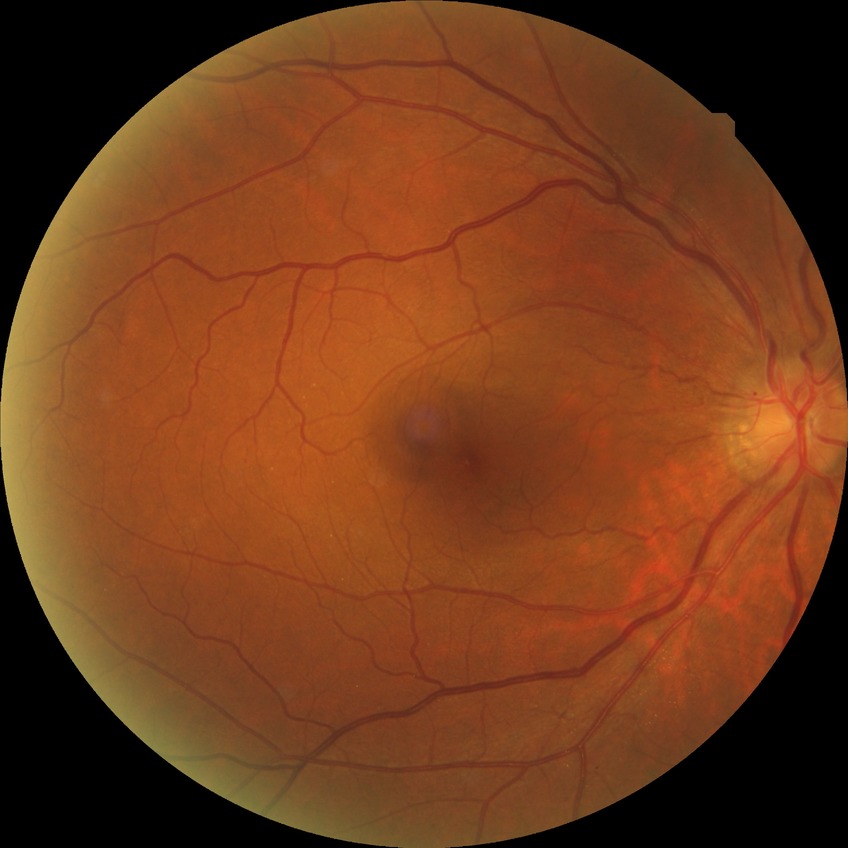

diabetic retinopathy (DR) = no diabetic retinopathy (NDR)